1932x1910px
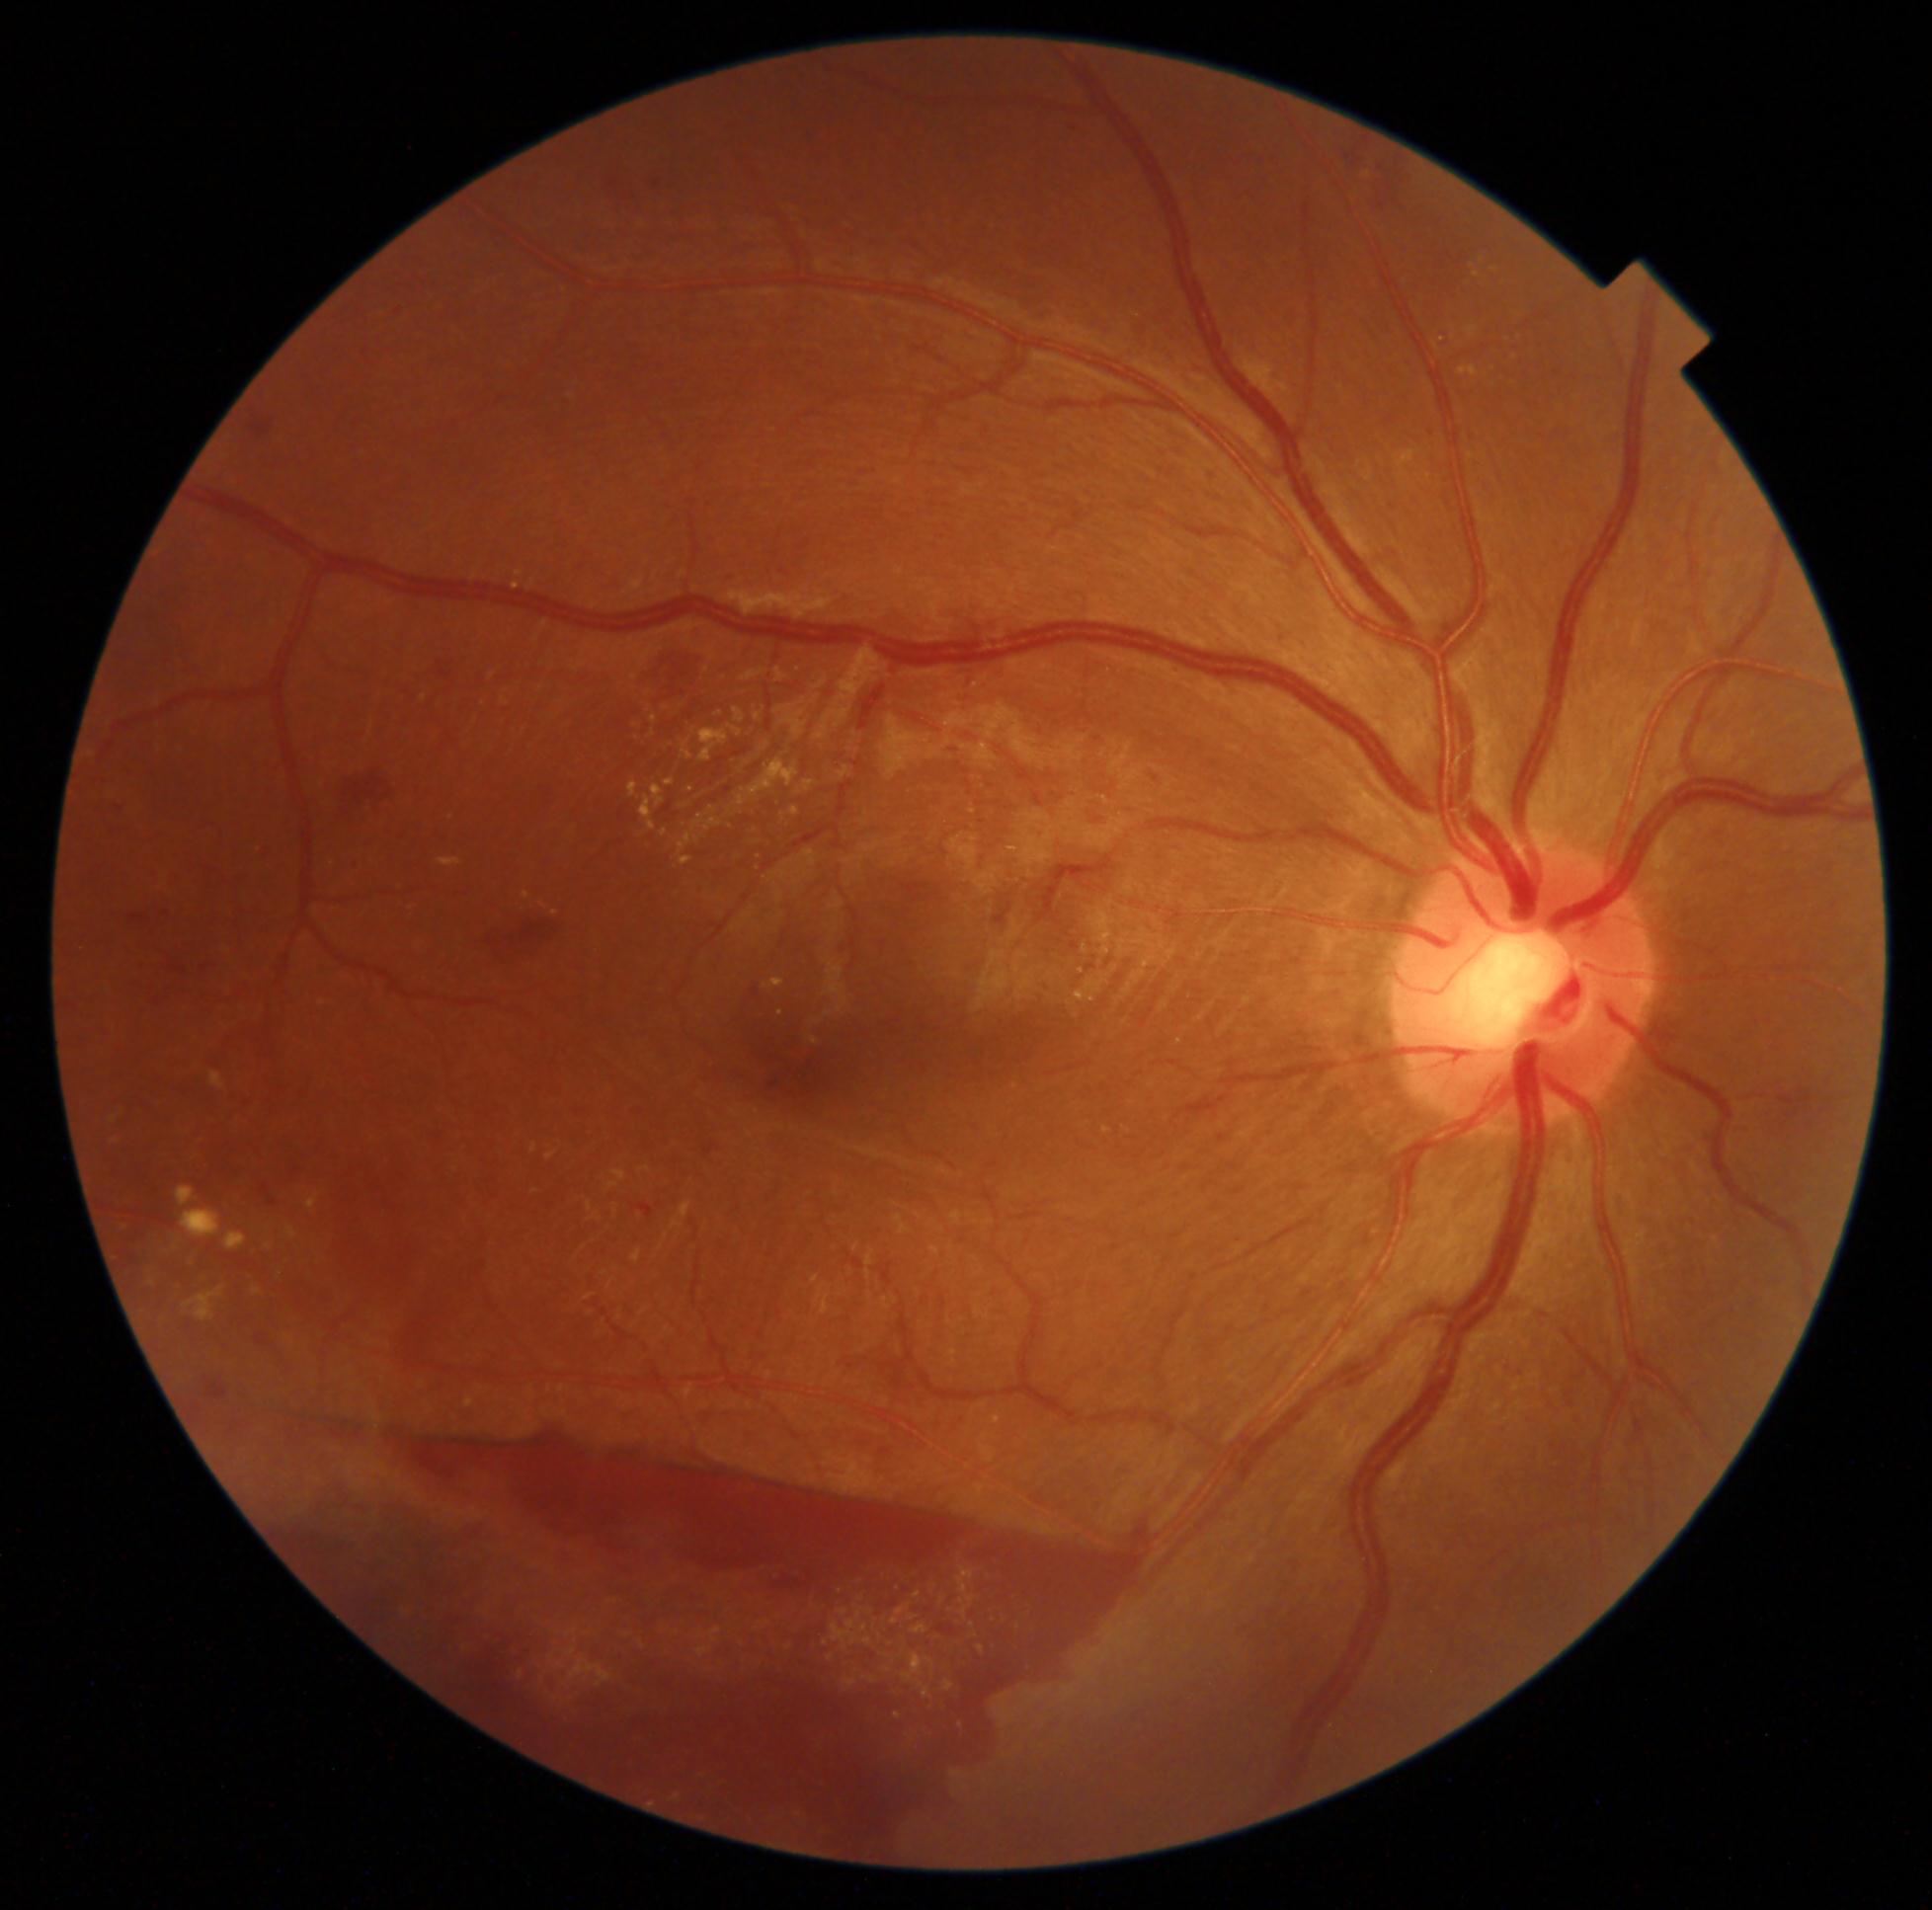

dr_category: proliferative diabetic retinopathy
dr_grade: 4